Infant wide-field retinal image — 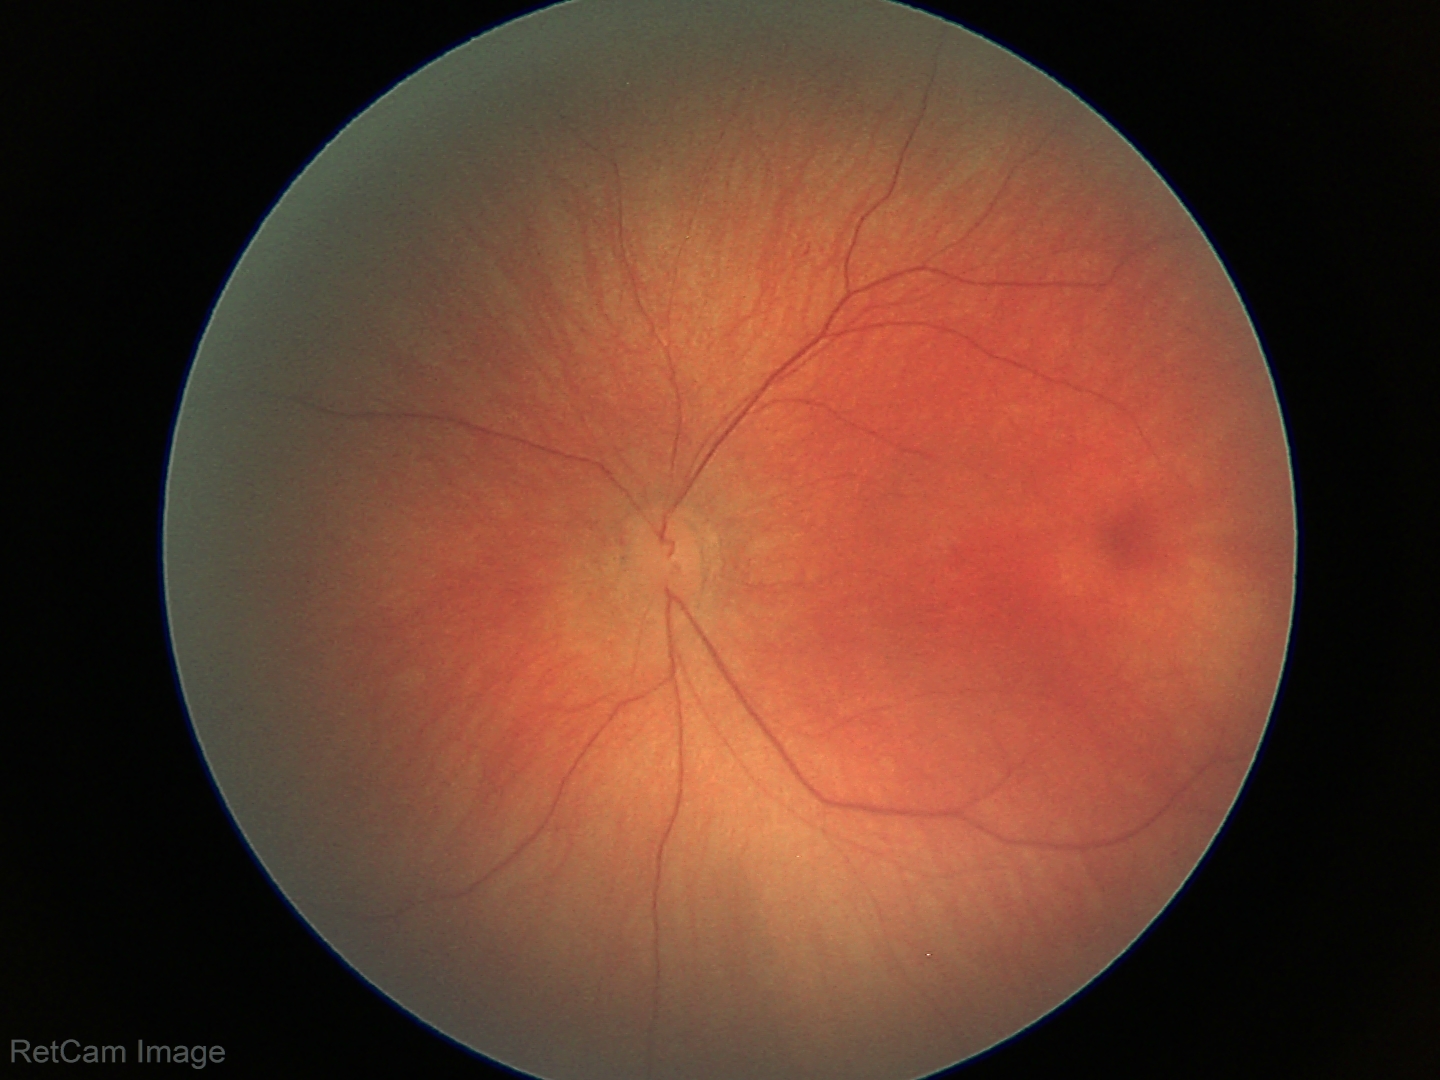
Screening examination with no abnormal retinal findings.